Diabetic retinopathy graded by the modified Davis classification; 848 by 848 pixels; color fundus photograph.
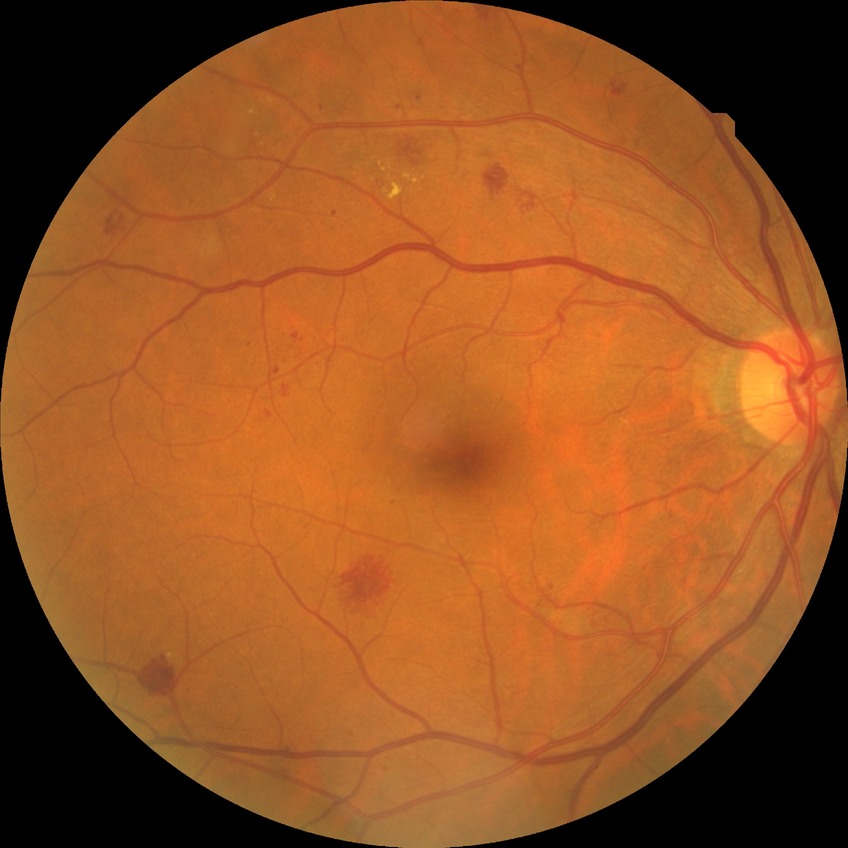
DR stage: SDR.